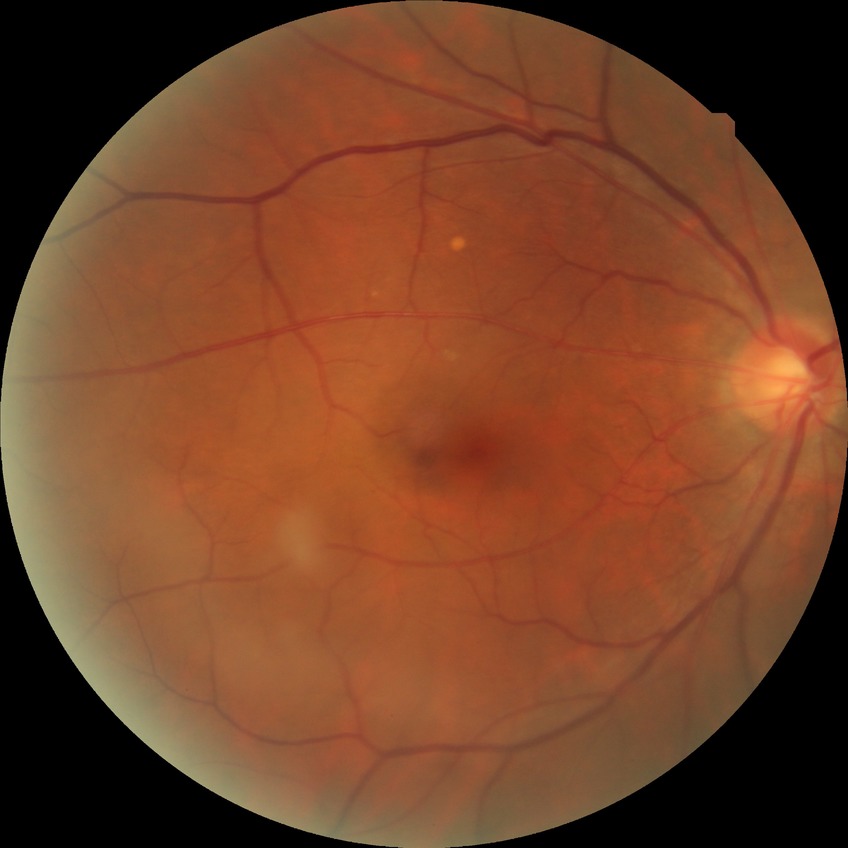

Diabetic retinopathy stage: no diabetic retinopathy.